Wide-field contact fundus photograph of an infant. Acquired on the Phoenix ICON:
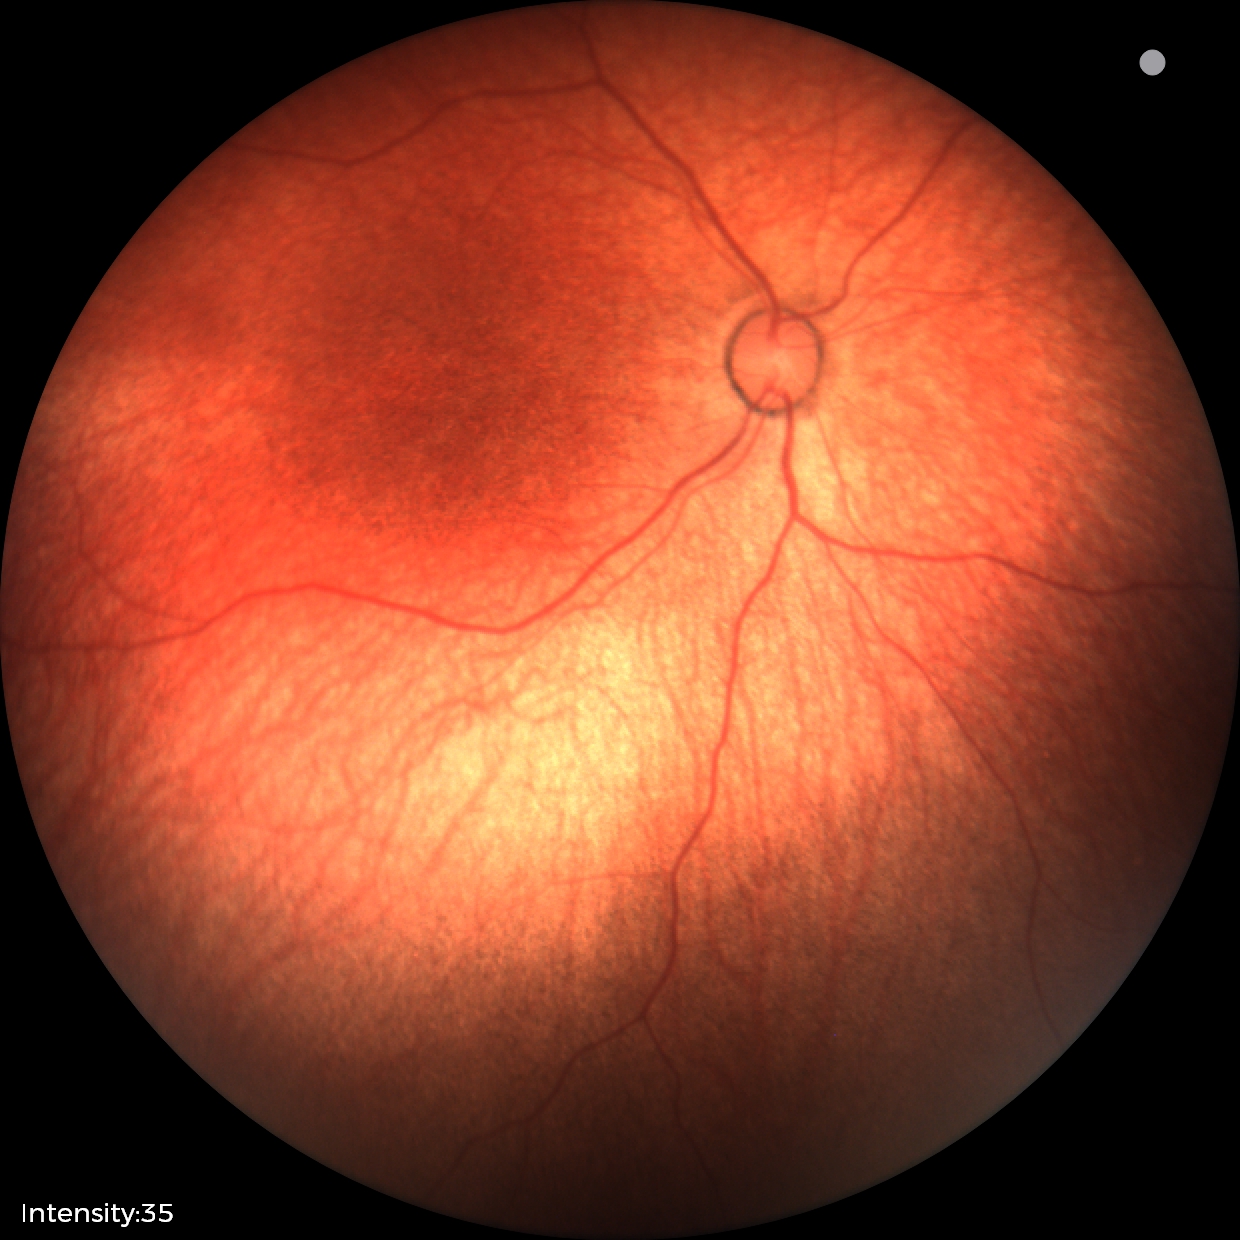

Physiological retinal appearance for postconceptual age.